Captured with the Clarity RetCam 3 (130° field of view); infant wide-field fundus photograph: 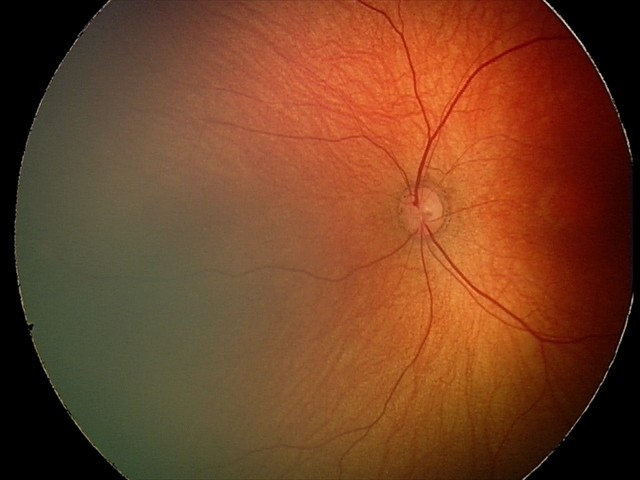 Impression: physiological appearance.